Pediatric retinal photograph (wide-field):
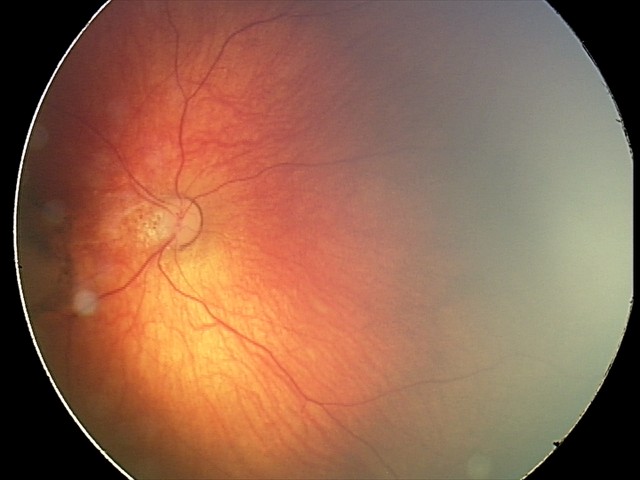
Impression = toxoplasmosis chorioretinitis.